Posterior pole photograph. Nonmydriatic — 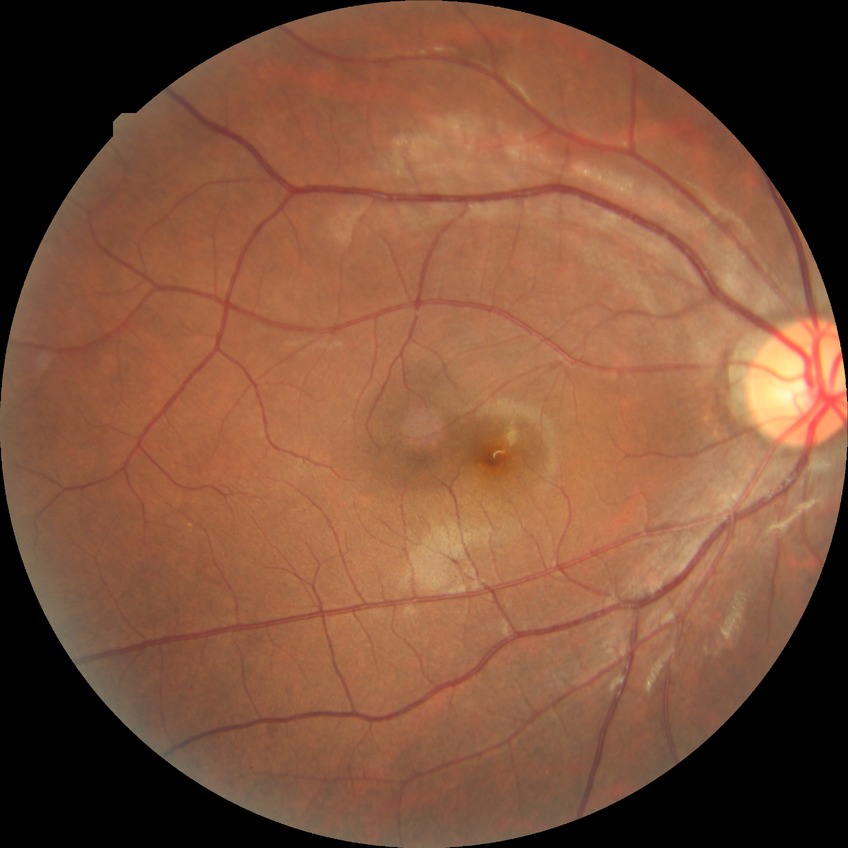
Diabetic retinopathy (DR) is no diabetic retinopathy (NDR).